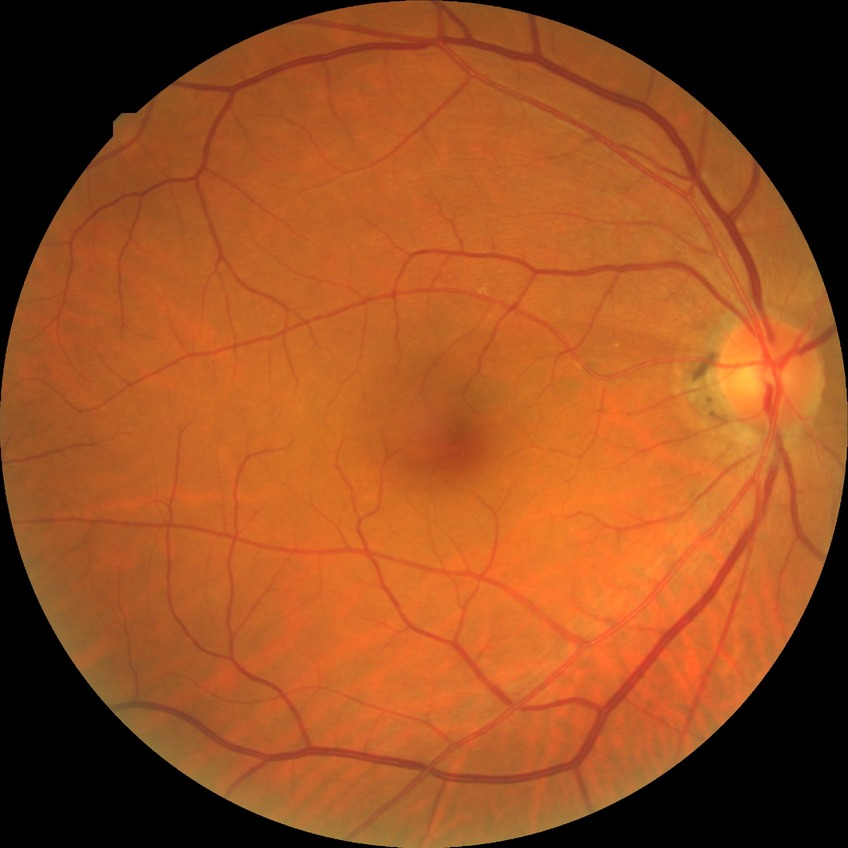
Diabetic retinopathy (DR) is no diabetic retinopathy (NDR).